Modified Davis classification · image size 848x848 · camera: NIDEK AFC-230 · 45-degree field of view · posterior pole color fundus photograph — 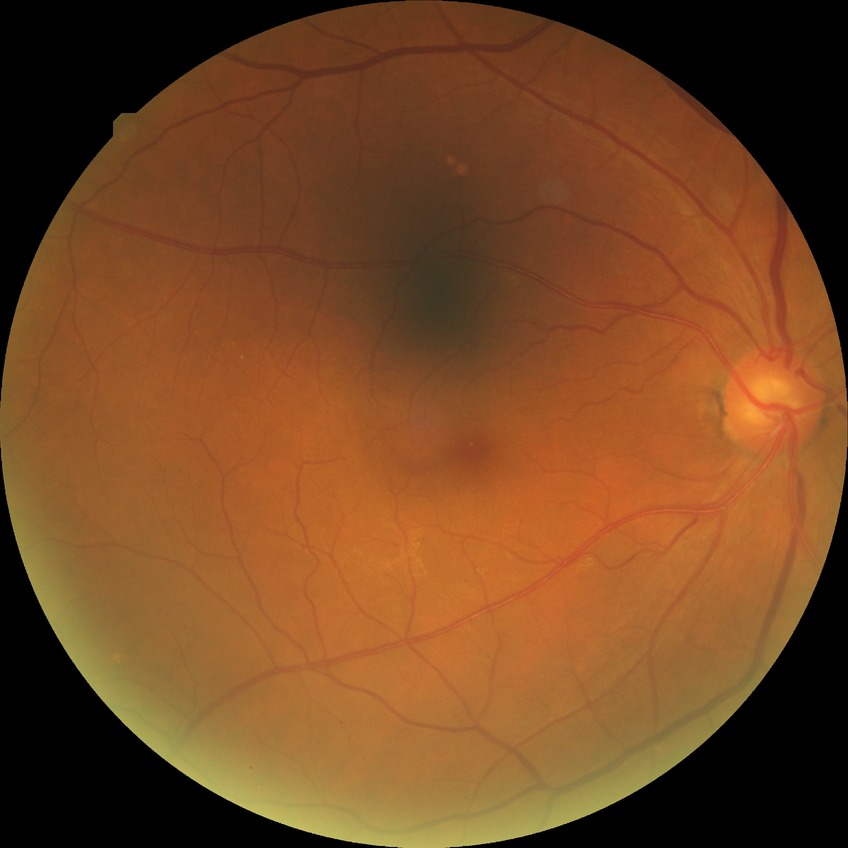 diabetic retinopathy stage: no diabetic retinopathy.